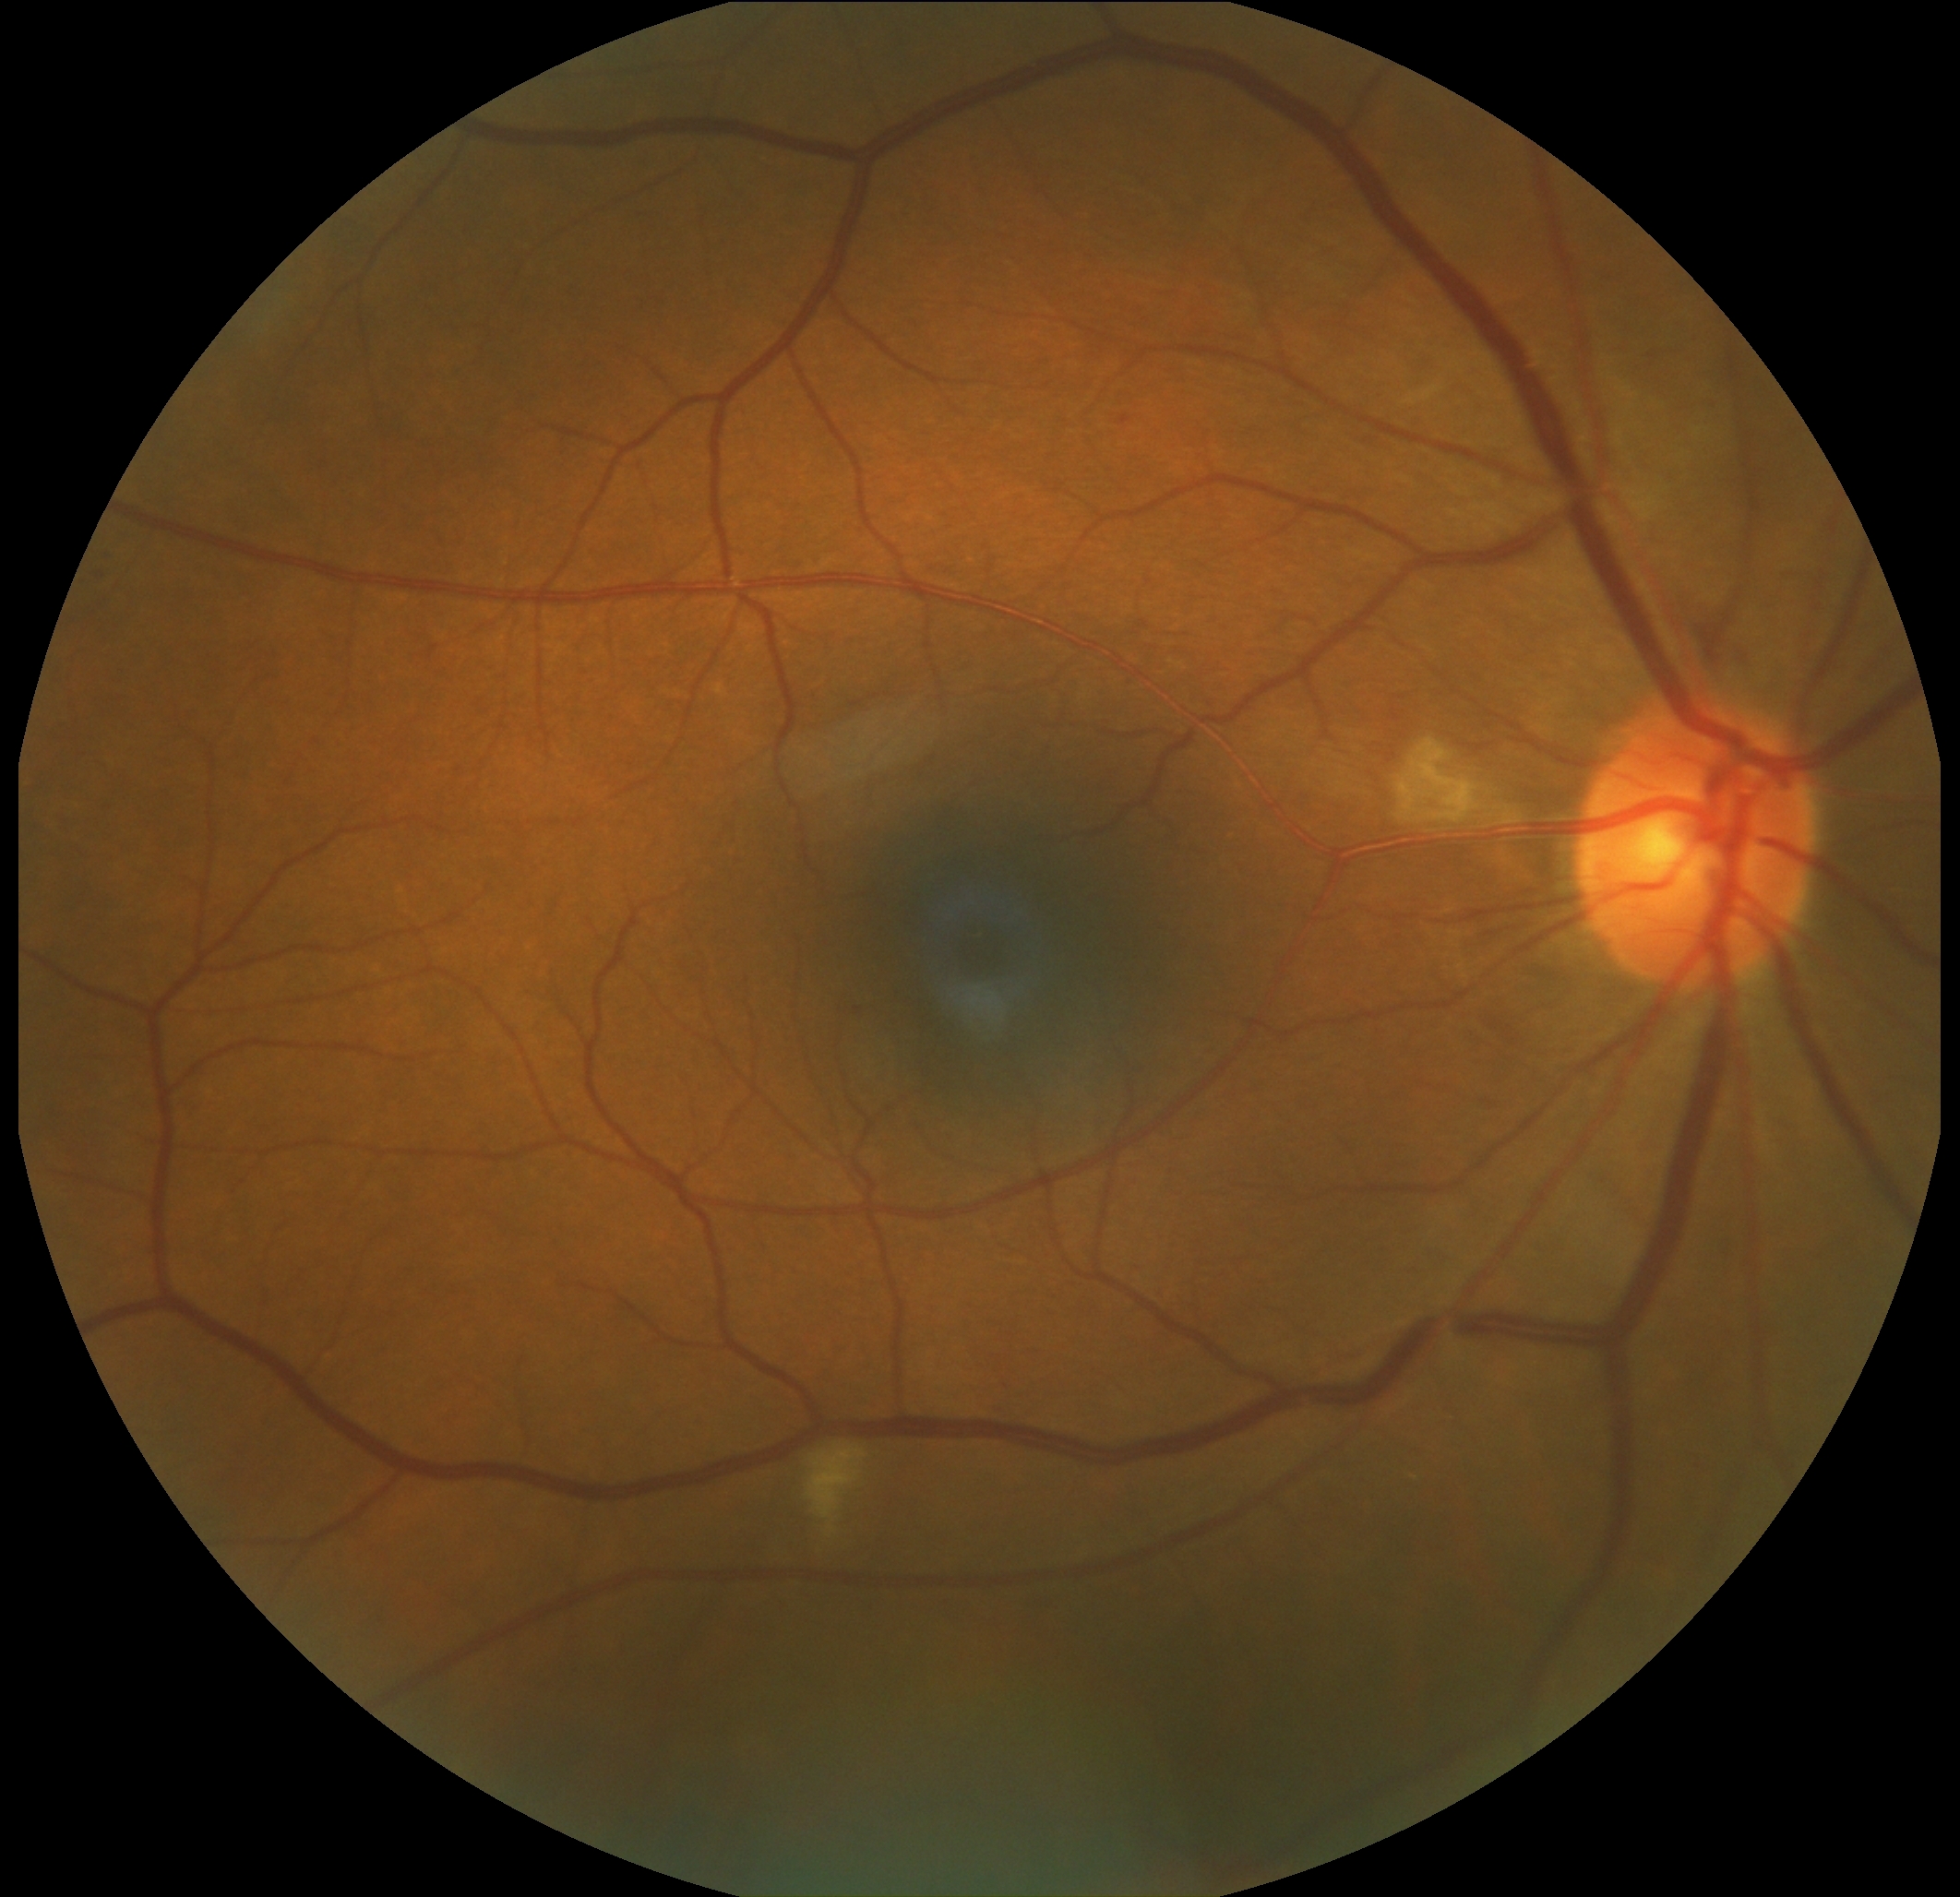
Disease class: non-proliferative diabetic retinopathy. Diabetic retinopathy grade: moderate non-proliferative diabetic retinopathy (2).